200° FOV. Ultra-widefield fundus mosaic.
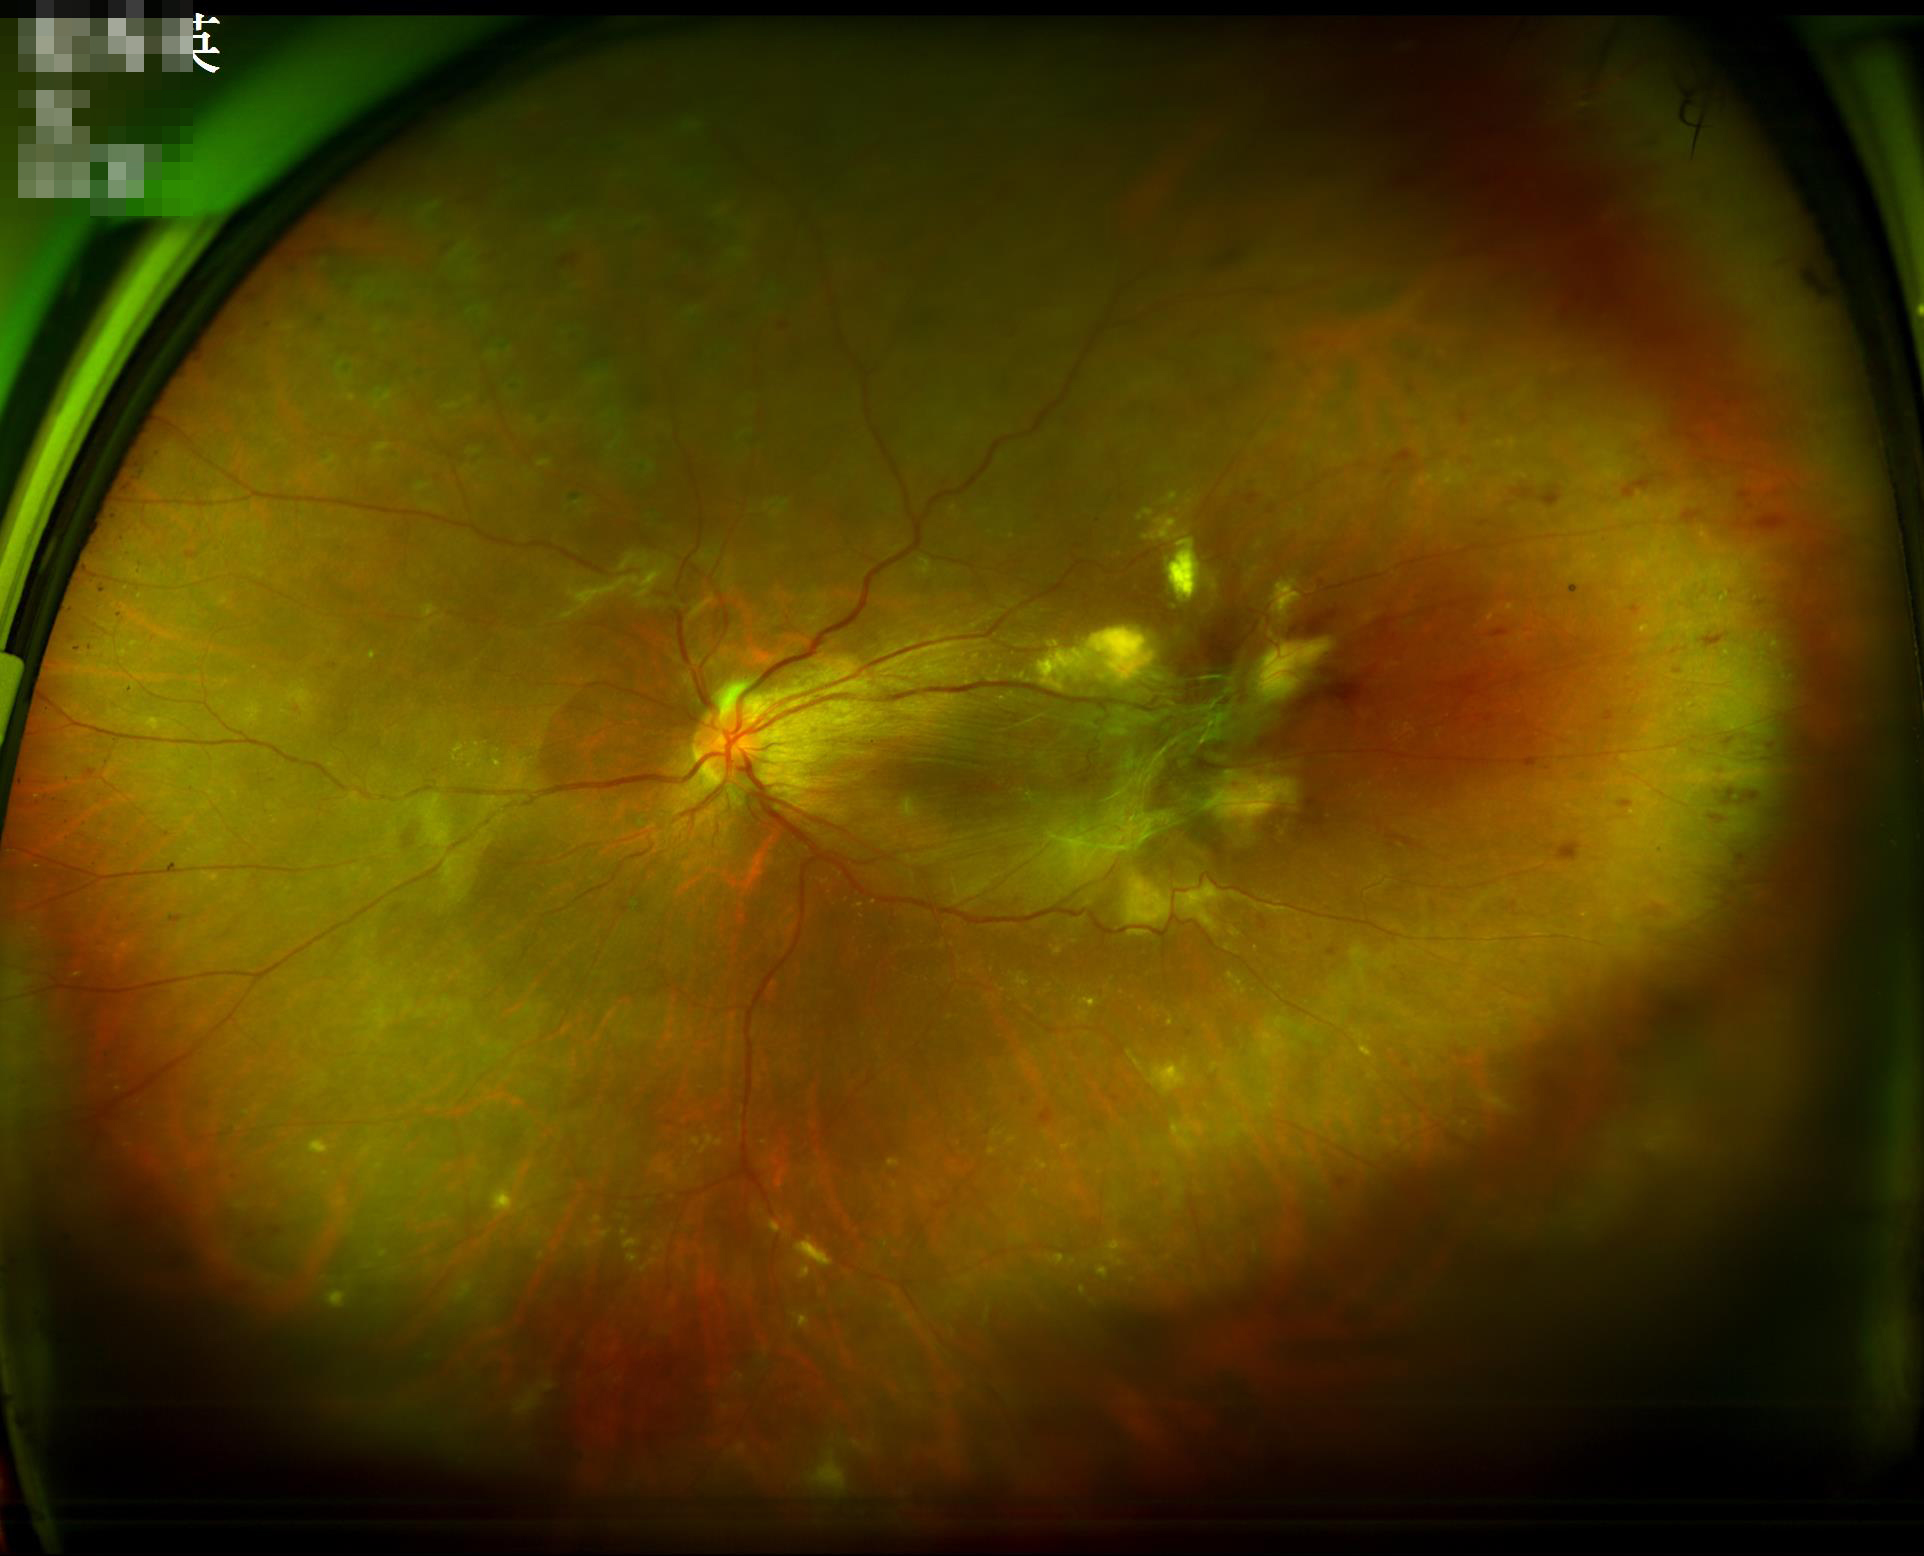

Quality grading: overall: poor and difficult to use diagnostically | illumination: no over- or under-exposure | clarity: reduced sharpness with visible blur | contrast: vessels and details readily distinguishable.